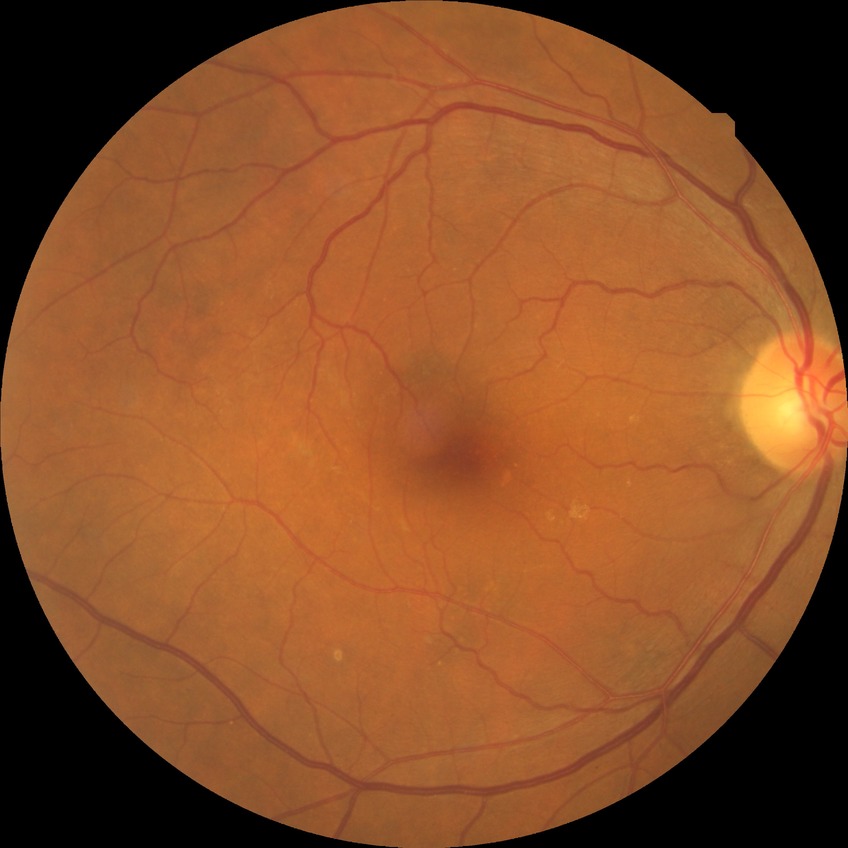

Findings:
* retinopathy stage — no diabetic retinopathy